848x848 · acquired with a NIDEK AFC-230 · CFP: 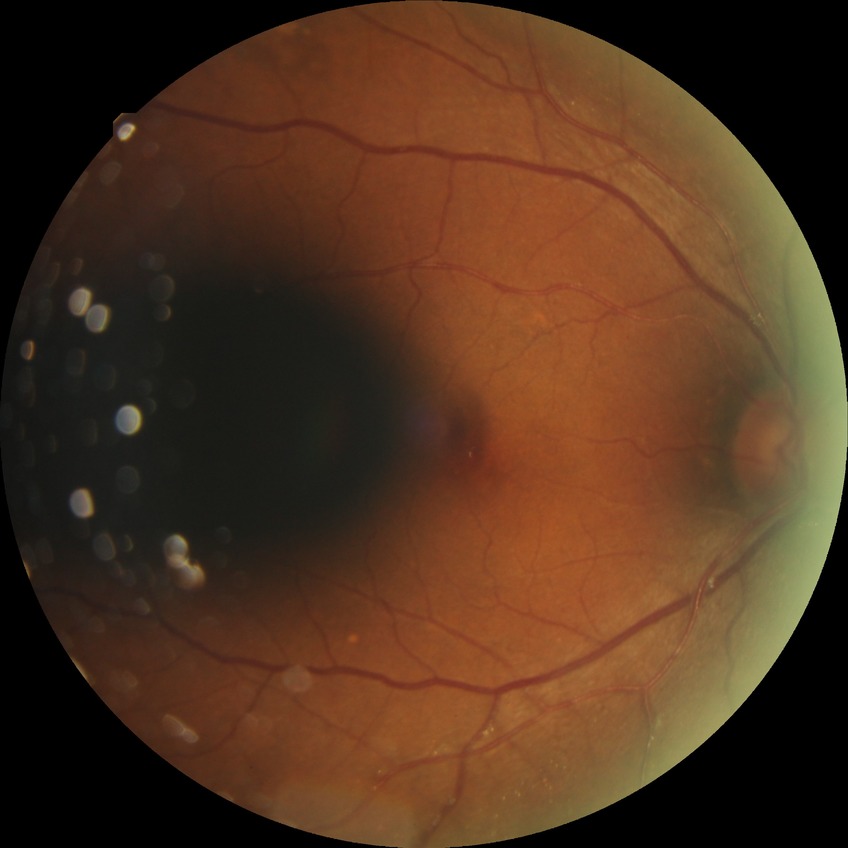
Diabetic retinopathy grade is simple diabetic retinopathy.